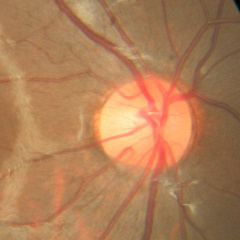
Color fundus photograph showing no evidence of glaucoma.